Infant wide-field retinal image: 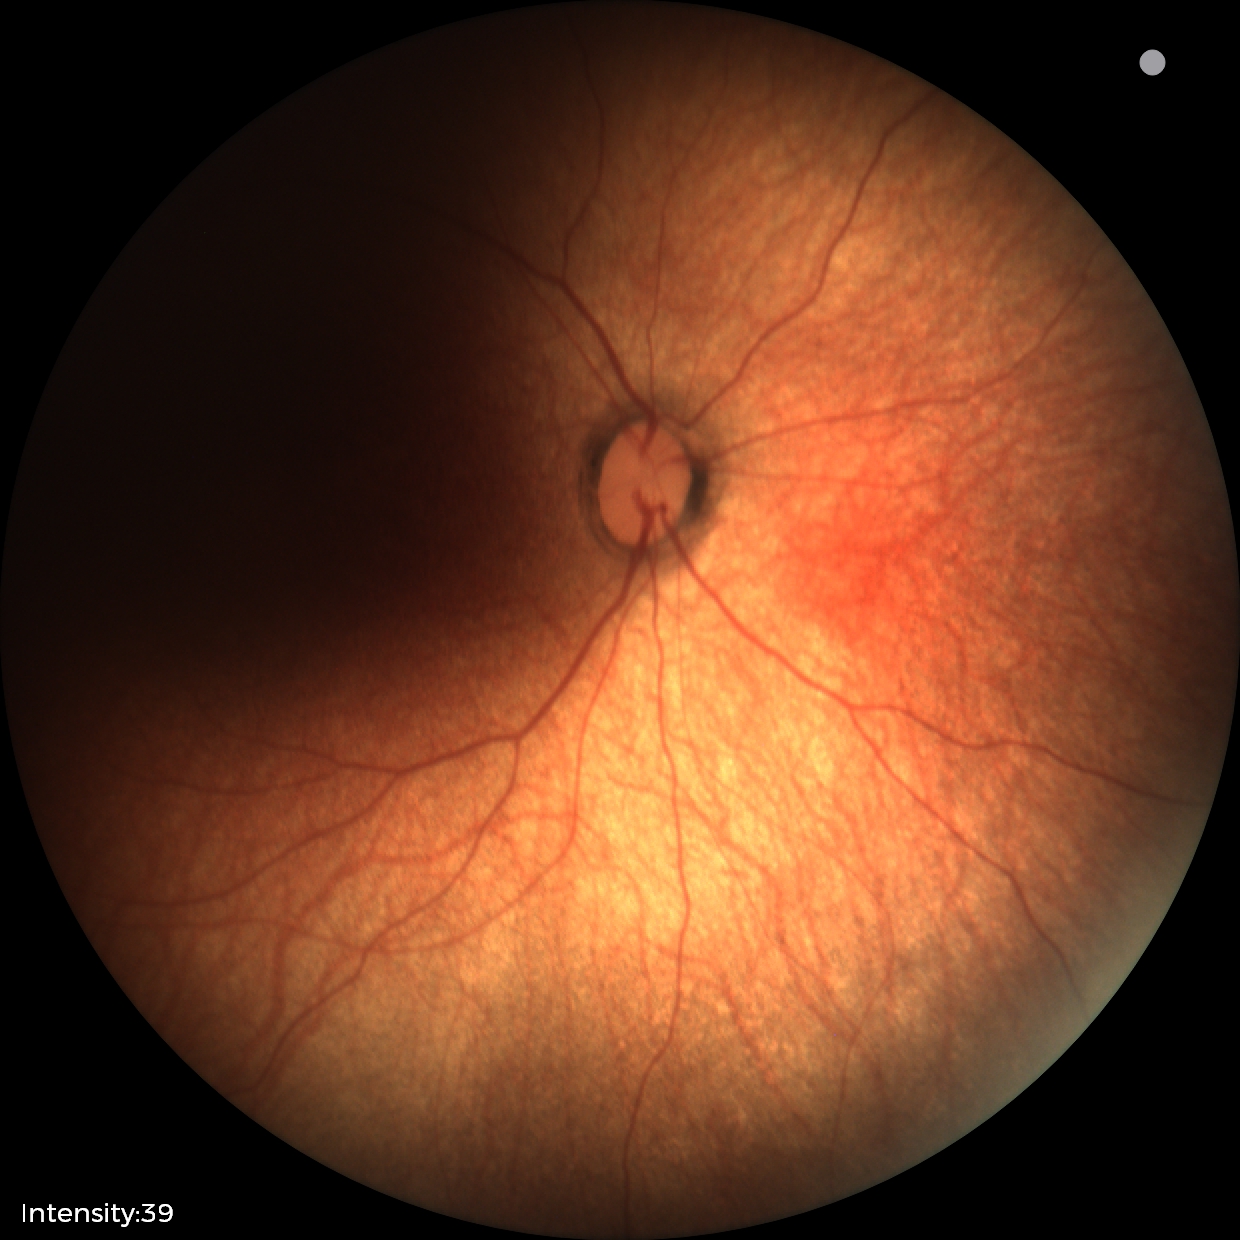

Screening examination with no abnormal retinal findings.